45 degree fundus photograph; NIDEK AFC-230:
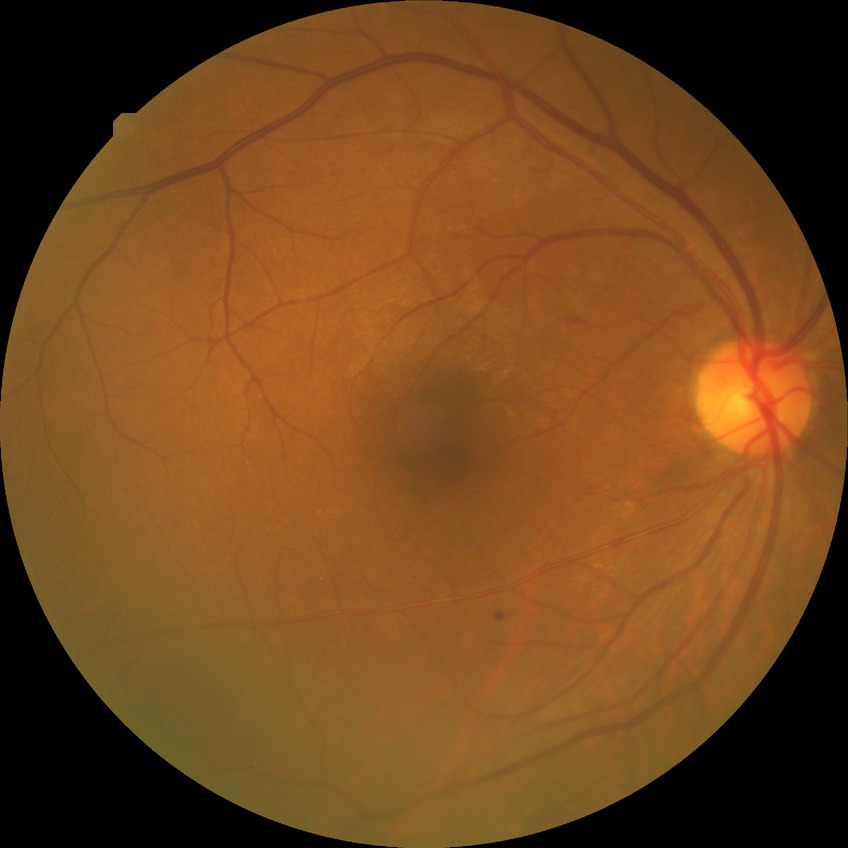
Retinopathy stage is simple diabetic retinopathy.